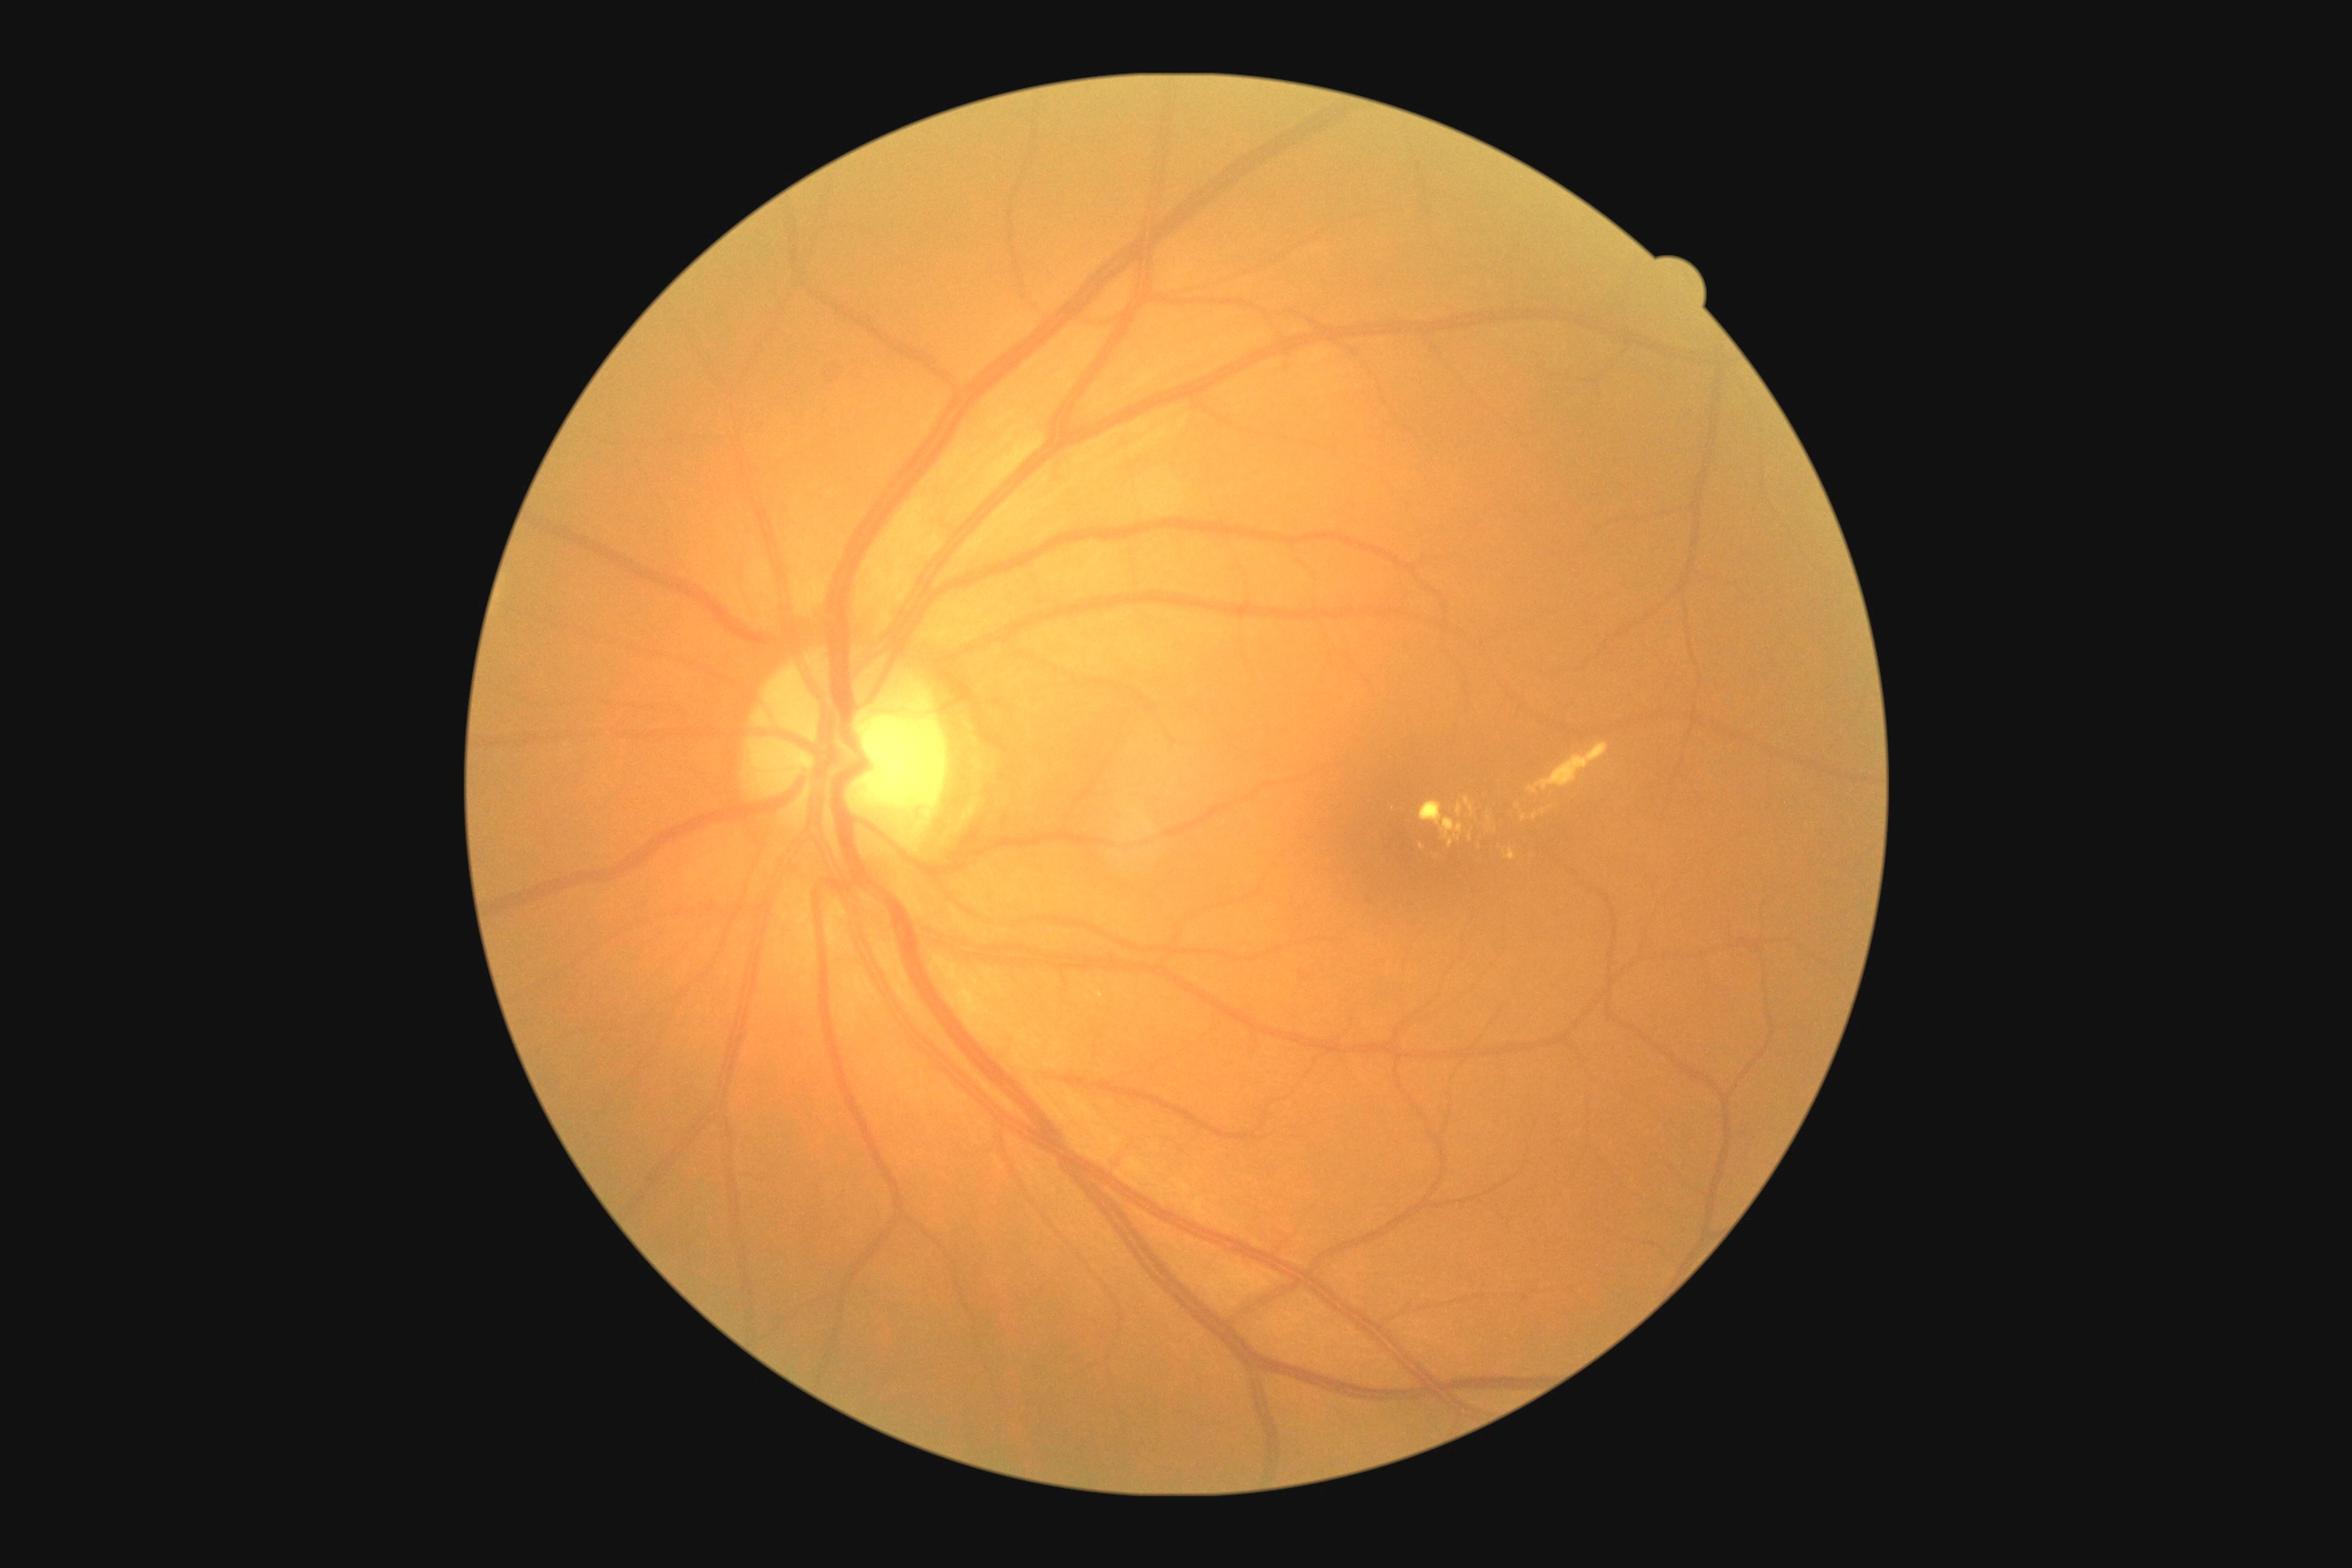

DR is grade 2 (moderate NPDR).